1240 x 1240 pixels · wide-field fundus image from infant ROP screening: 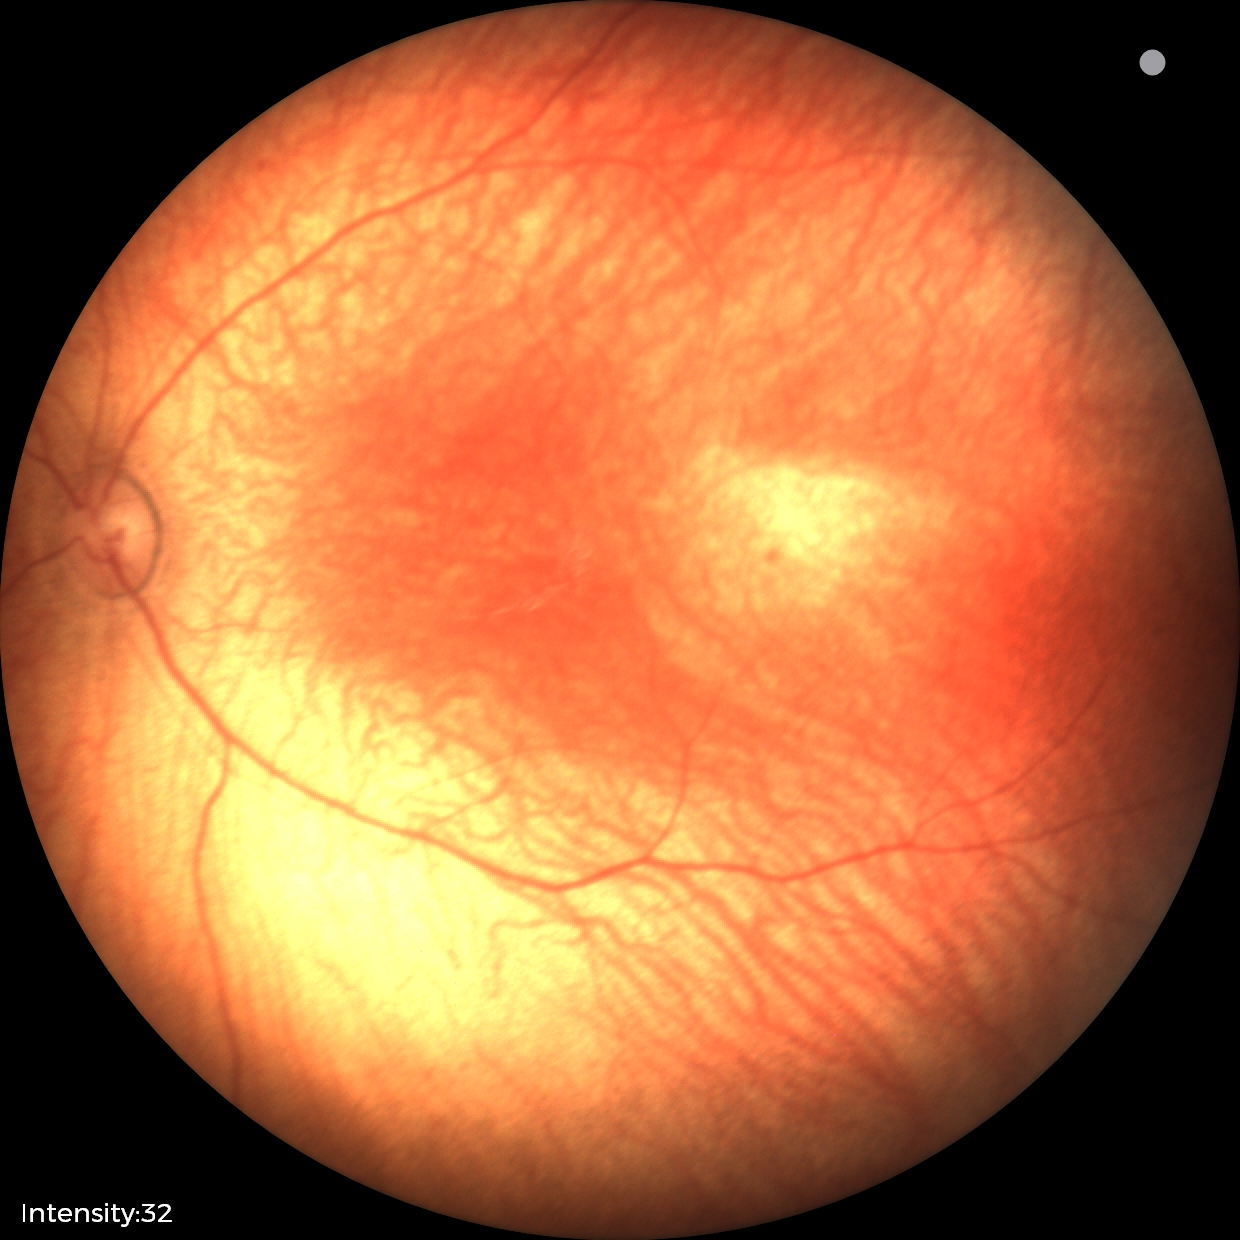
Assessment: no abnormal retinal findings.